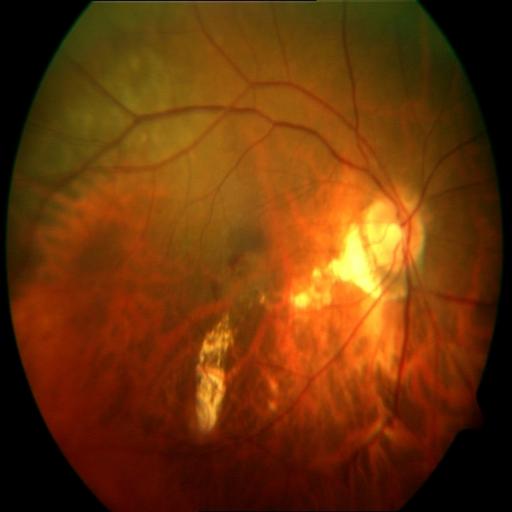

Fundus appearance consistent with MYA (myopia).